Optic disc-centered crop from a color fundus photograph:
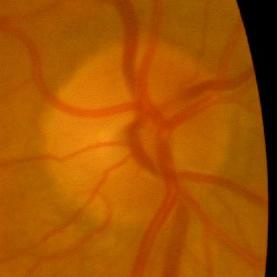 Findings consistent with no glaucomatous changes.